45-degree field of view, fundus photo.
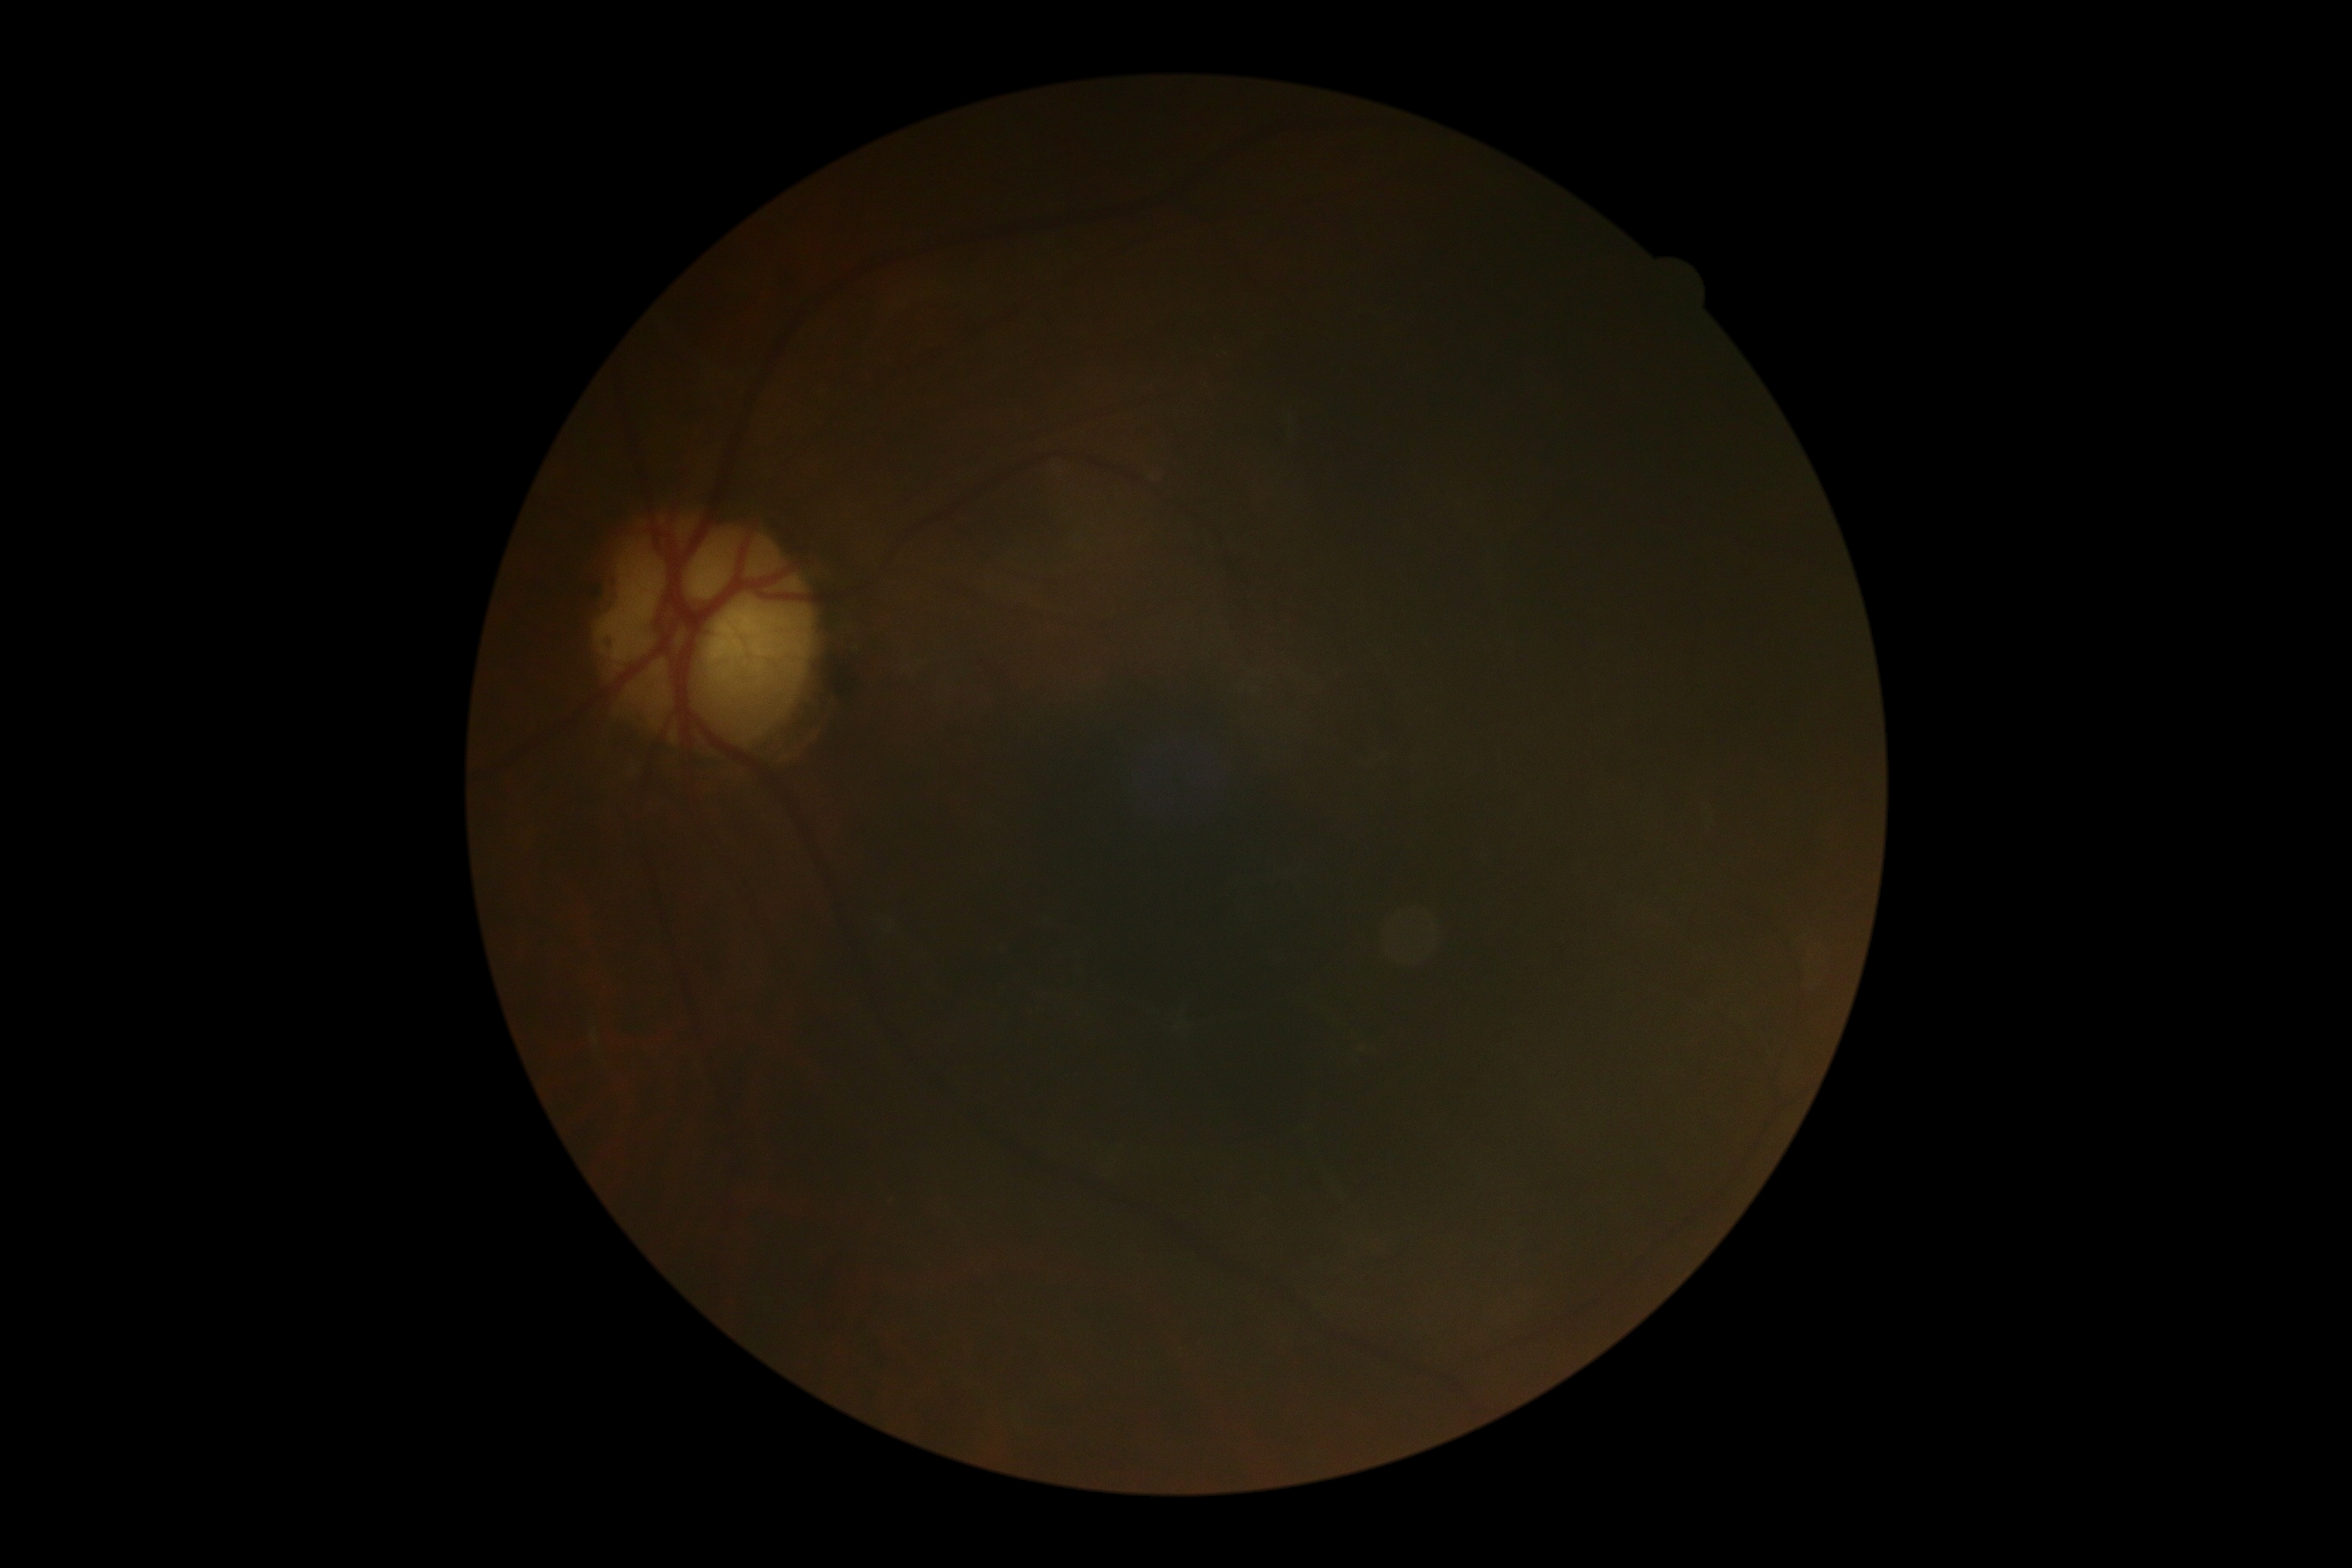

The image cannot be graded for diabetic retinopathy. Diabetic retinopathy (DR) is ungradable.